Wide-field fundus photograph from neonatal ROP screening; captured with the Clarity RetCam 3 (130° field of view)
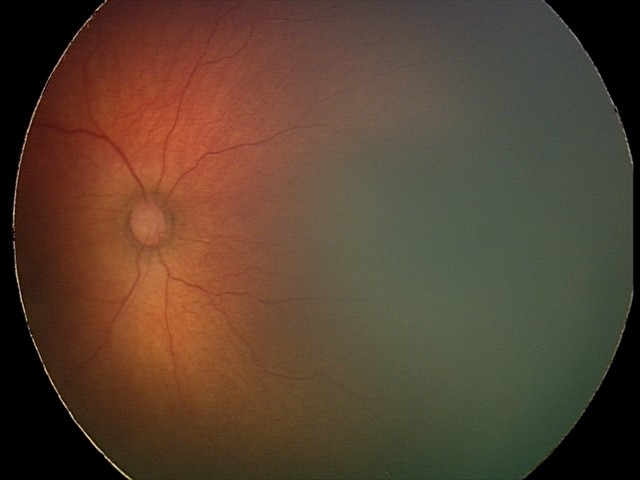 Diagnosis from this screening exam: status post retinopathy of prematurity — retinal appearance after treated retinopathy of prematurity. Plus disease absent.